Camera: Clarity RetCam 3 (130° FOV). Wide-field fundus photograph of an infant
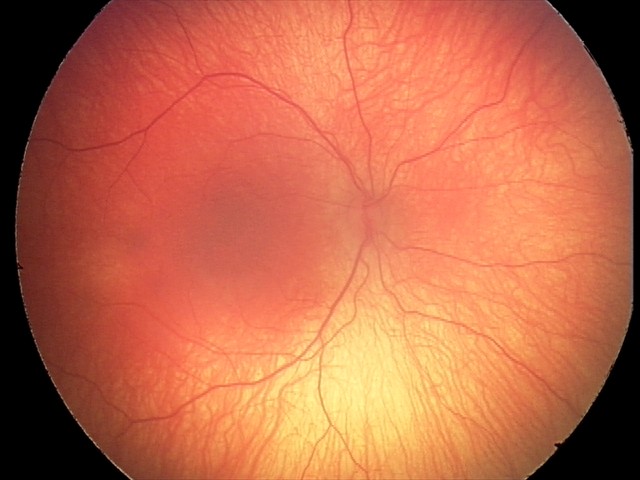

Q: Plus disease status?
A: no plus disease — posterior pole vessels without abnormal dilation or tortuosity
Q: What is the screening diagnosis?
A: ROP stage 2 — ridge with height and width at the demarcation line